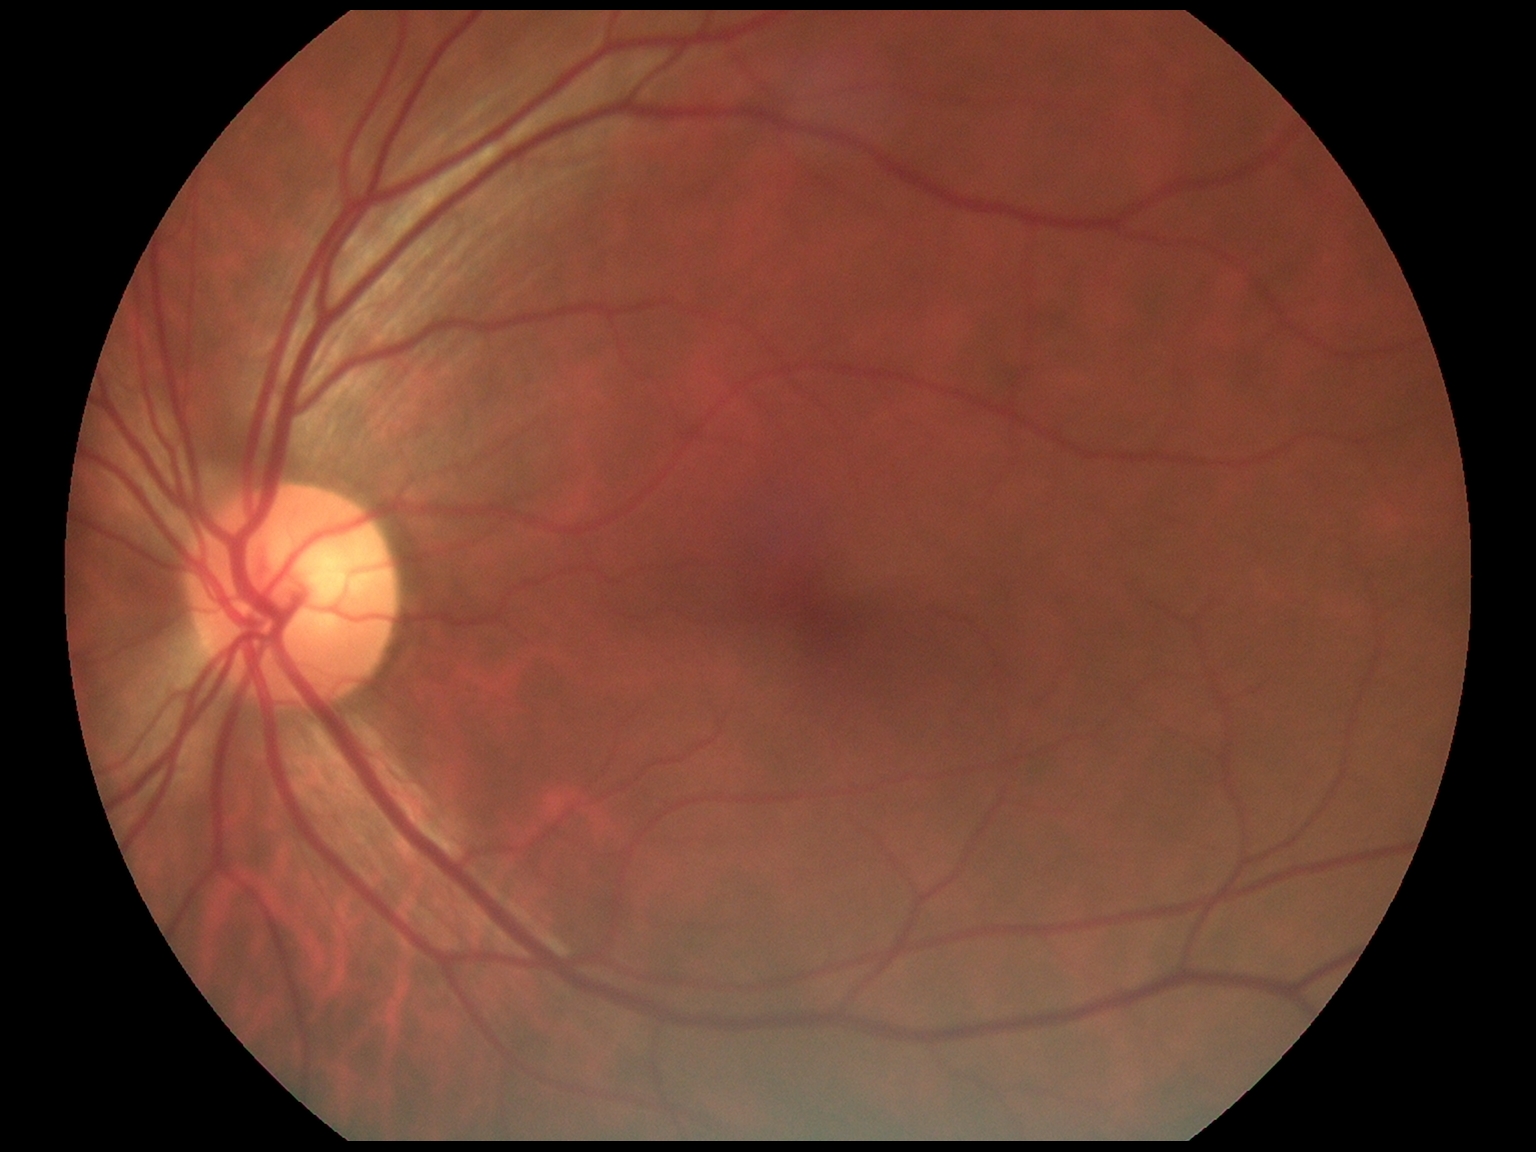

DR severity: no apparent diabetic retinopathy (grade 0).